848 x 848 pixels; color fundus photograph: 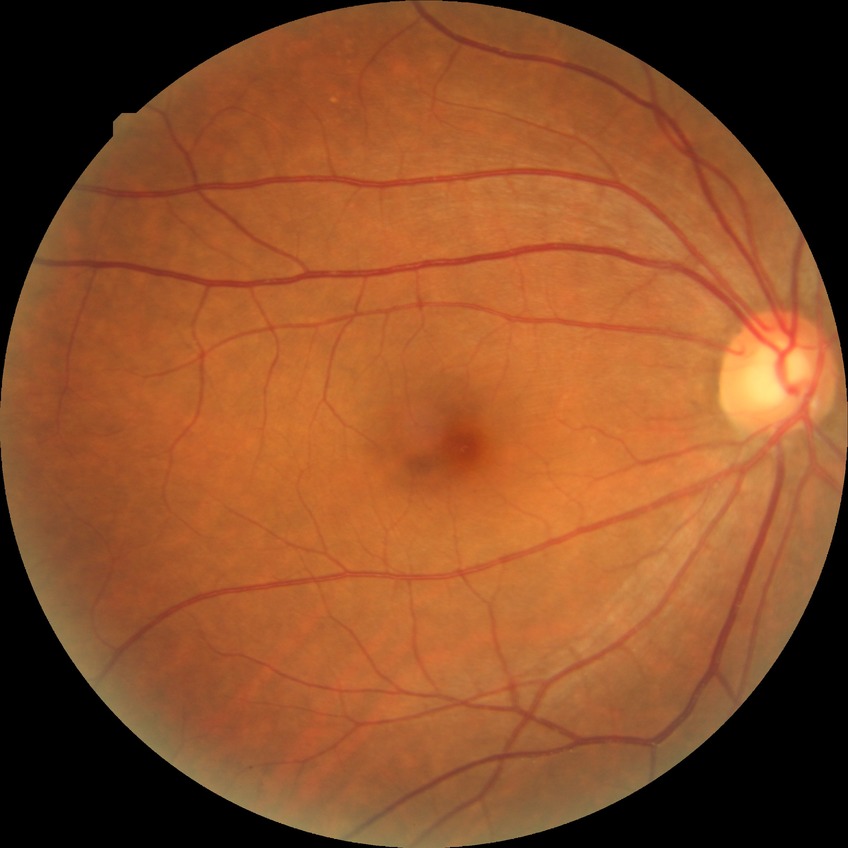

Retinopathy stage is no diabetic retinopathy.